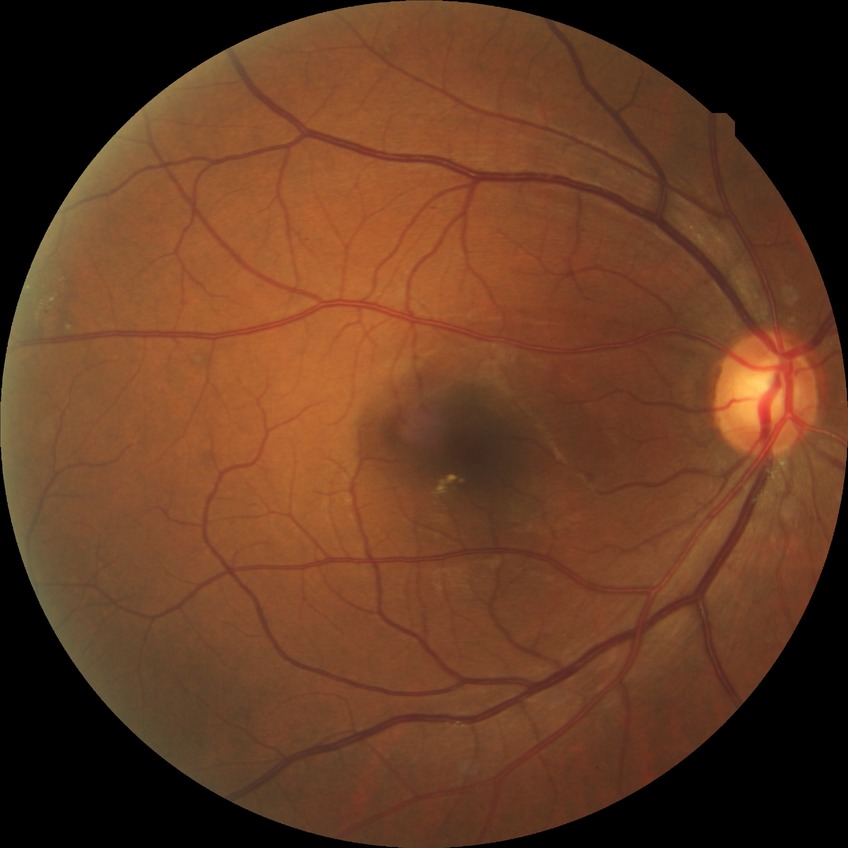
diabetic retinopathy (DR) = SDR (simple diabetic retinopathy)